848 x 848 pixels:
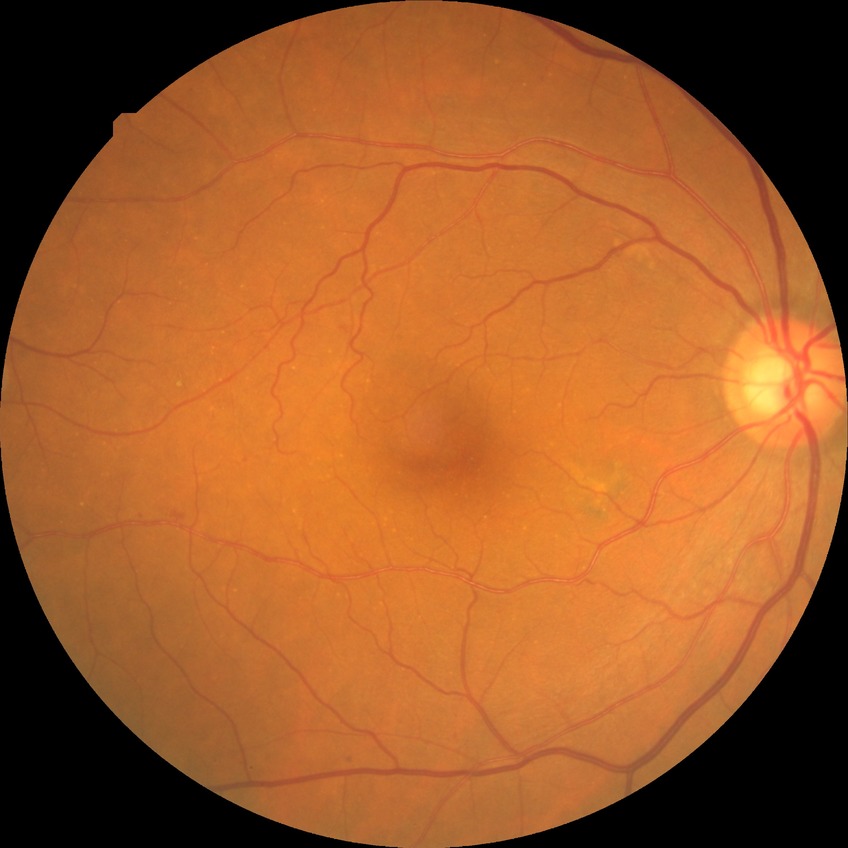
{"davis_grade": "no diabetic retinopathy"}